512 x 512 pixels: 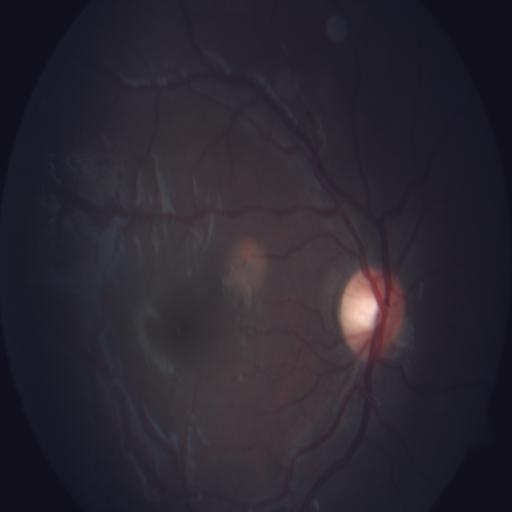

There is evidence of RD (retinal detachment).